1380x1382, retinal fundus photograph — 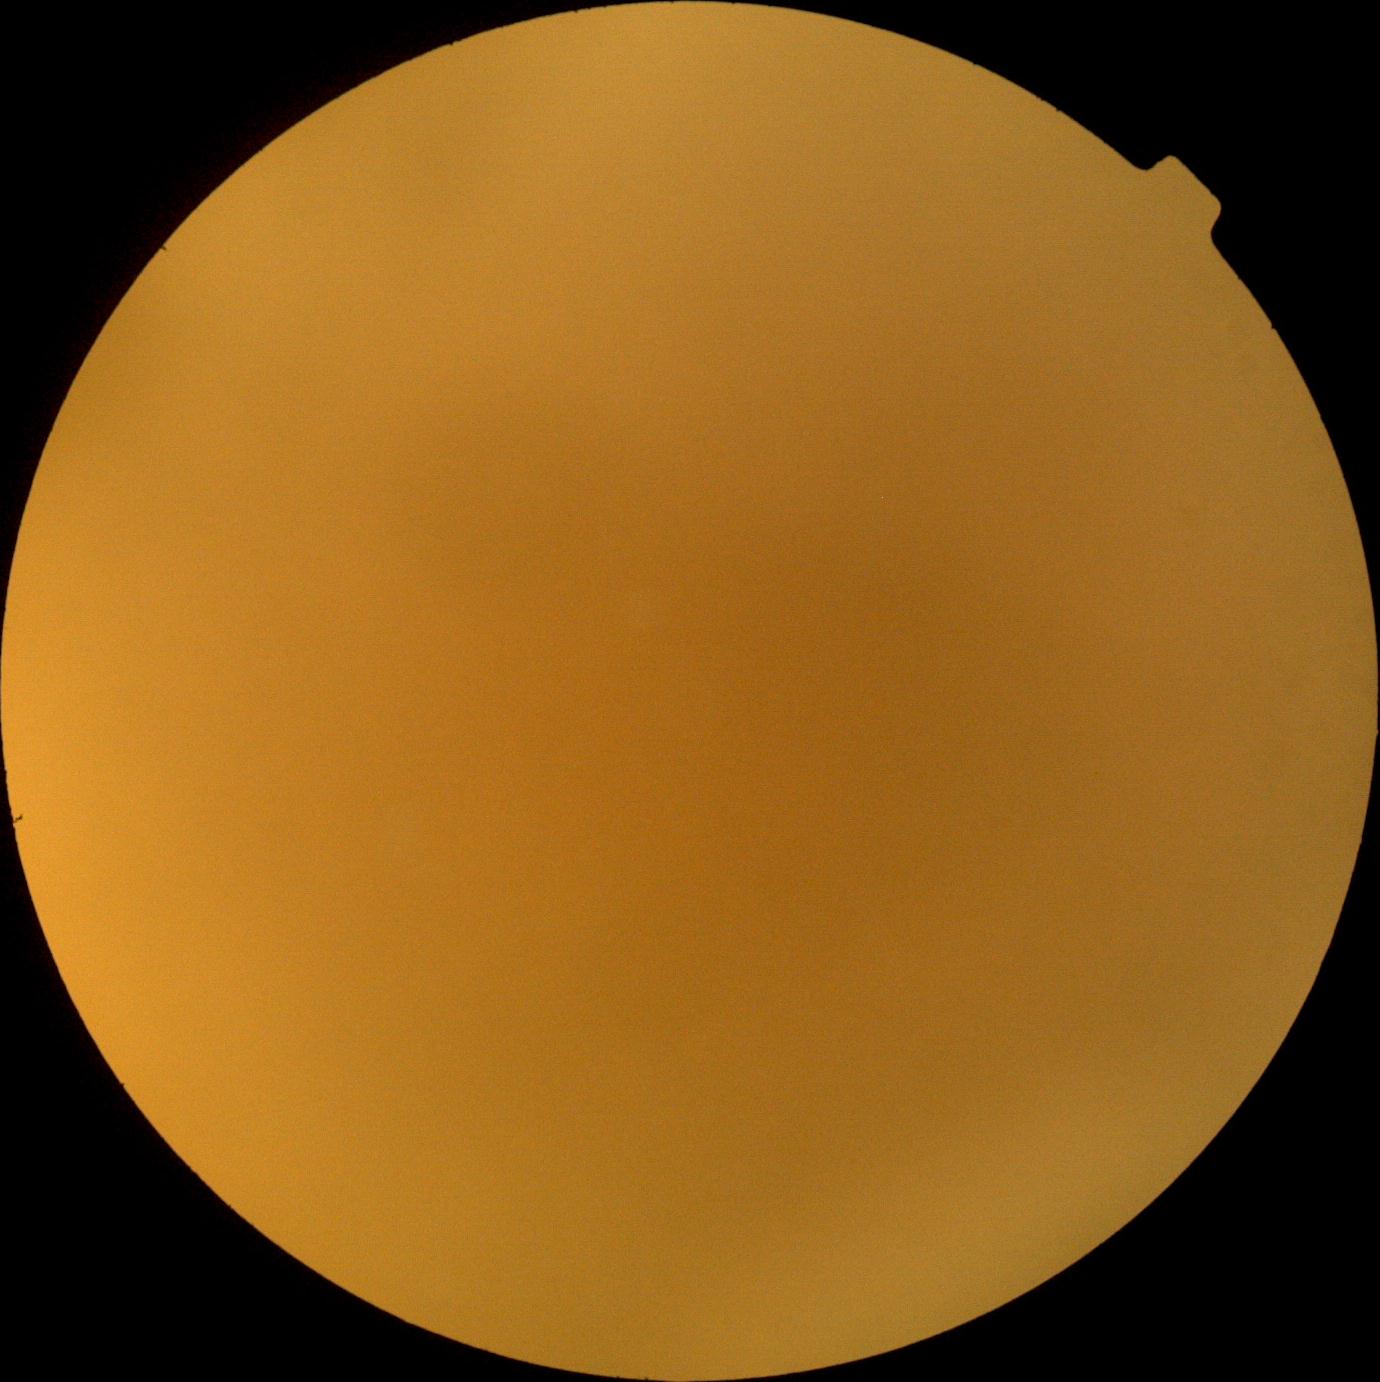
DR stage = ungradable.